Tabletop color fundus camera image:
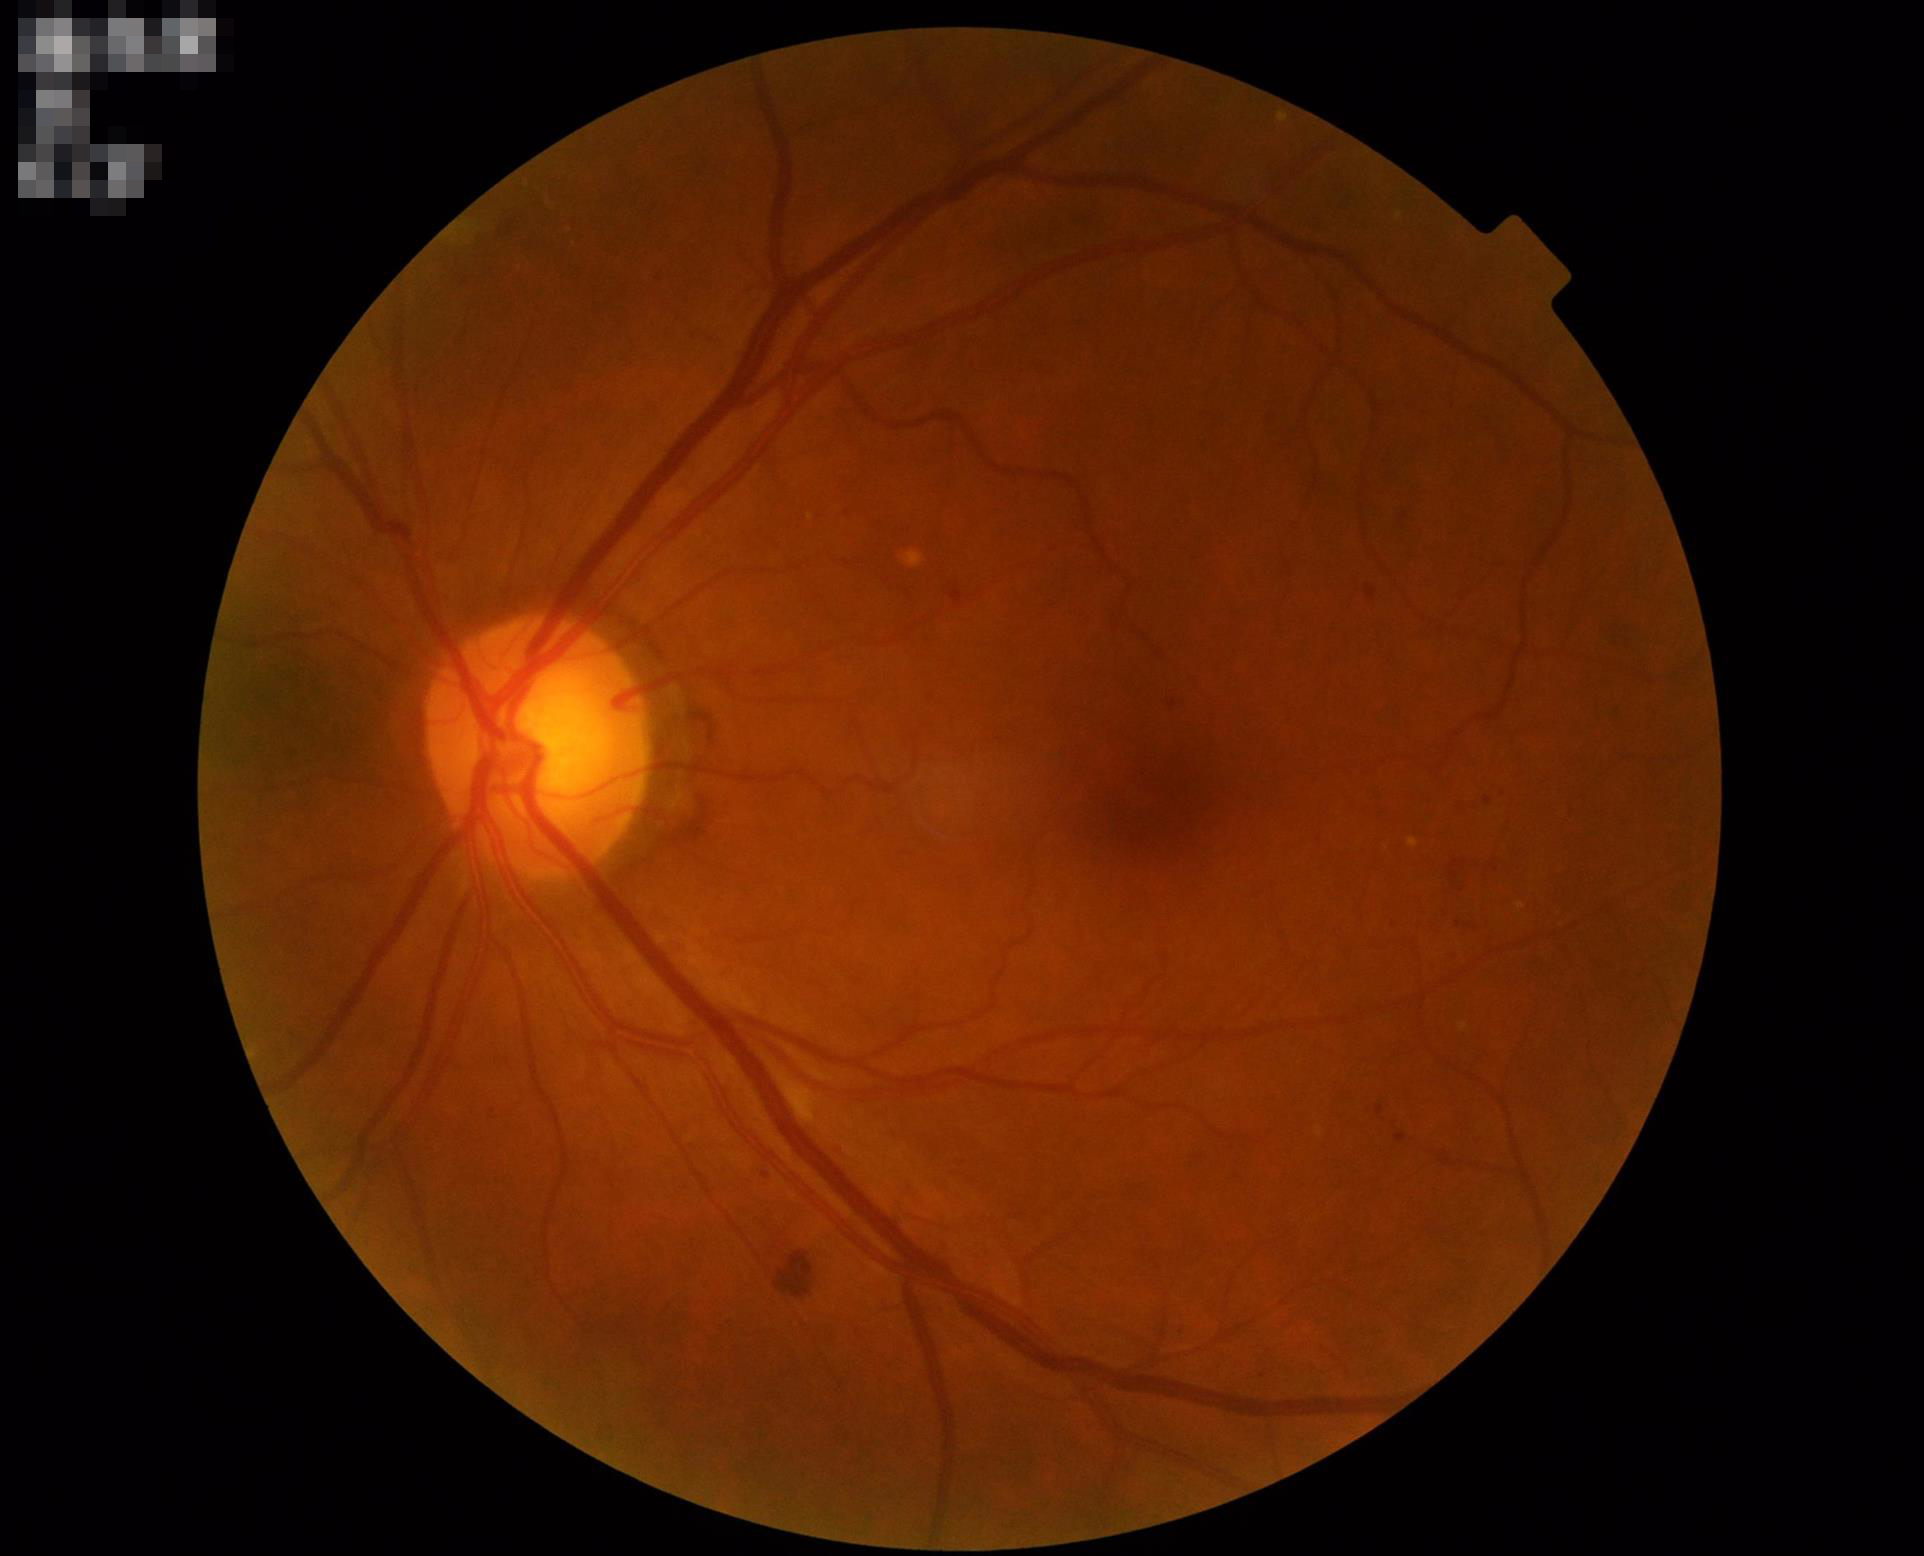

Image quality is adequate for diagnostic use. Illumination is even. Image is sharp throughout the field.